2352x1568px. Color fundus photograph.
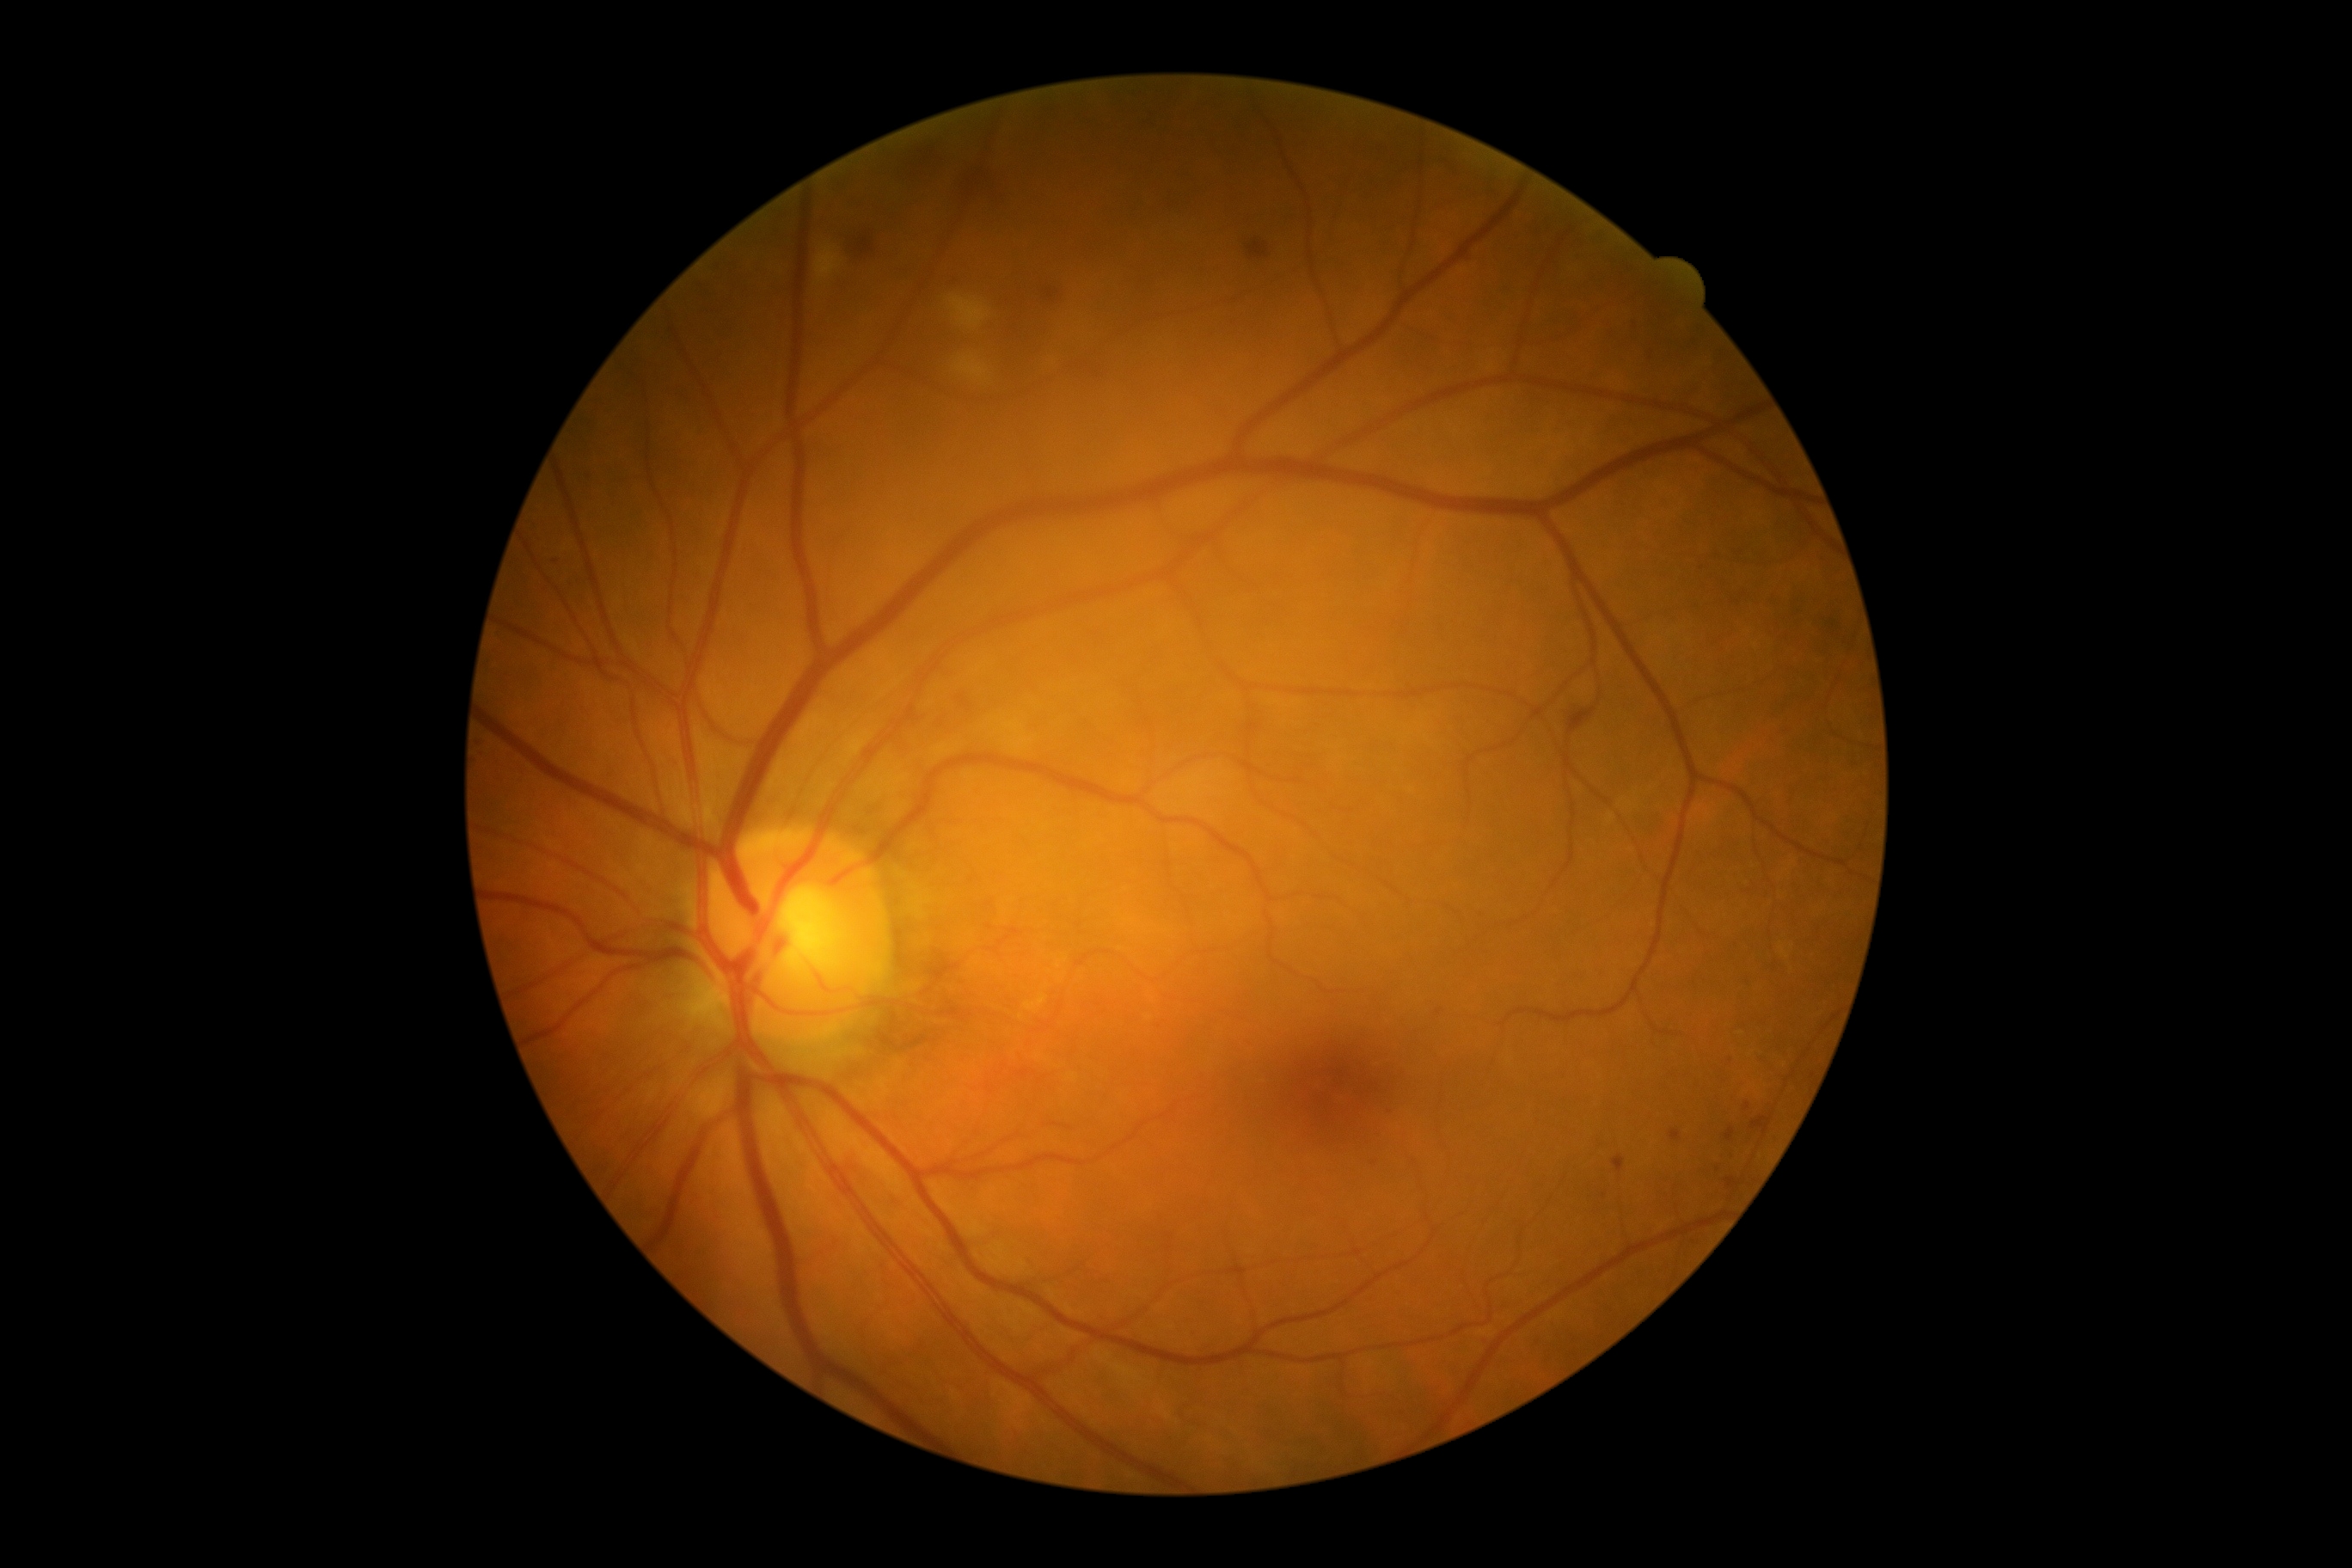
DR stage is moderate non-proliferative diabetic retinopathy (grade 2).